CFP
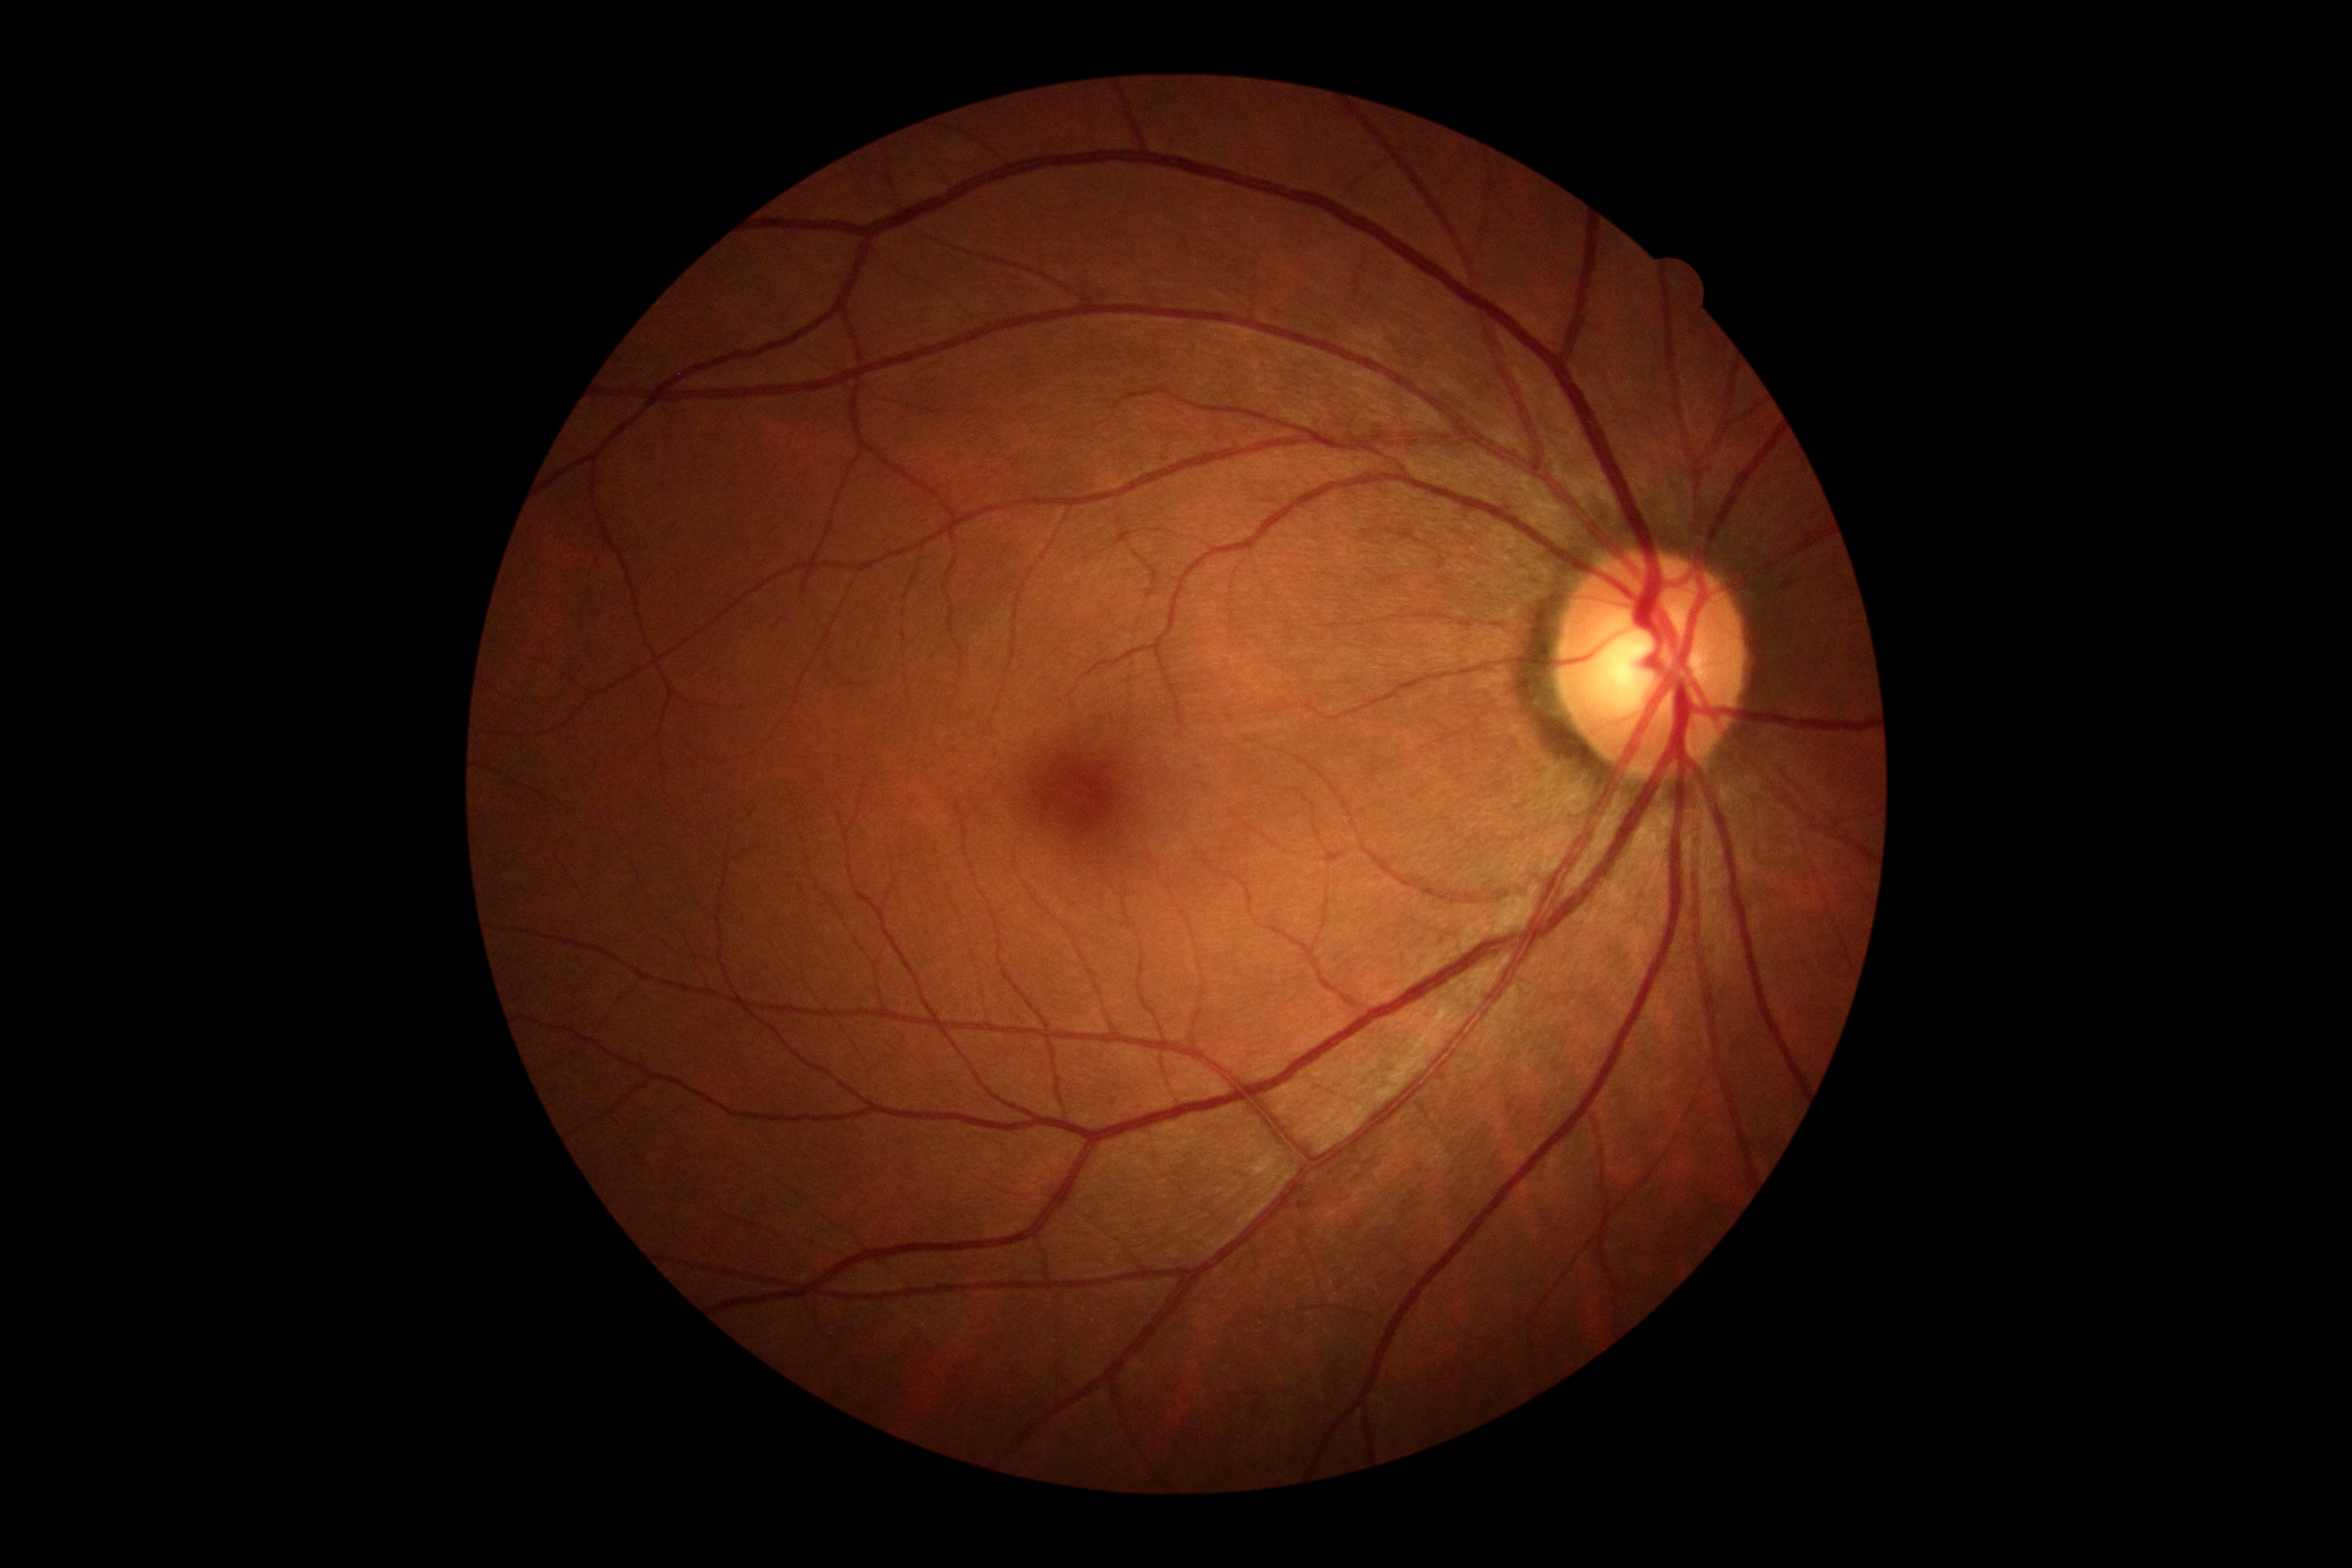 diabetic retinopathy severity: no apparent retinopathy (grade 0).